45° FOV; color fundus image
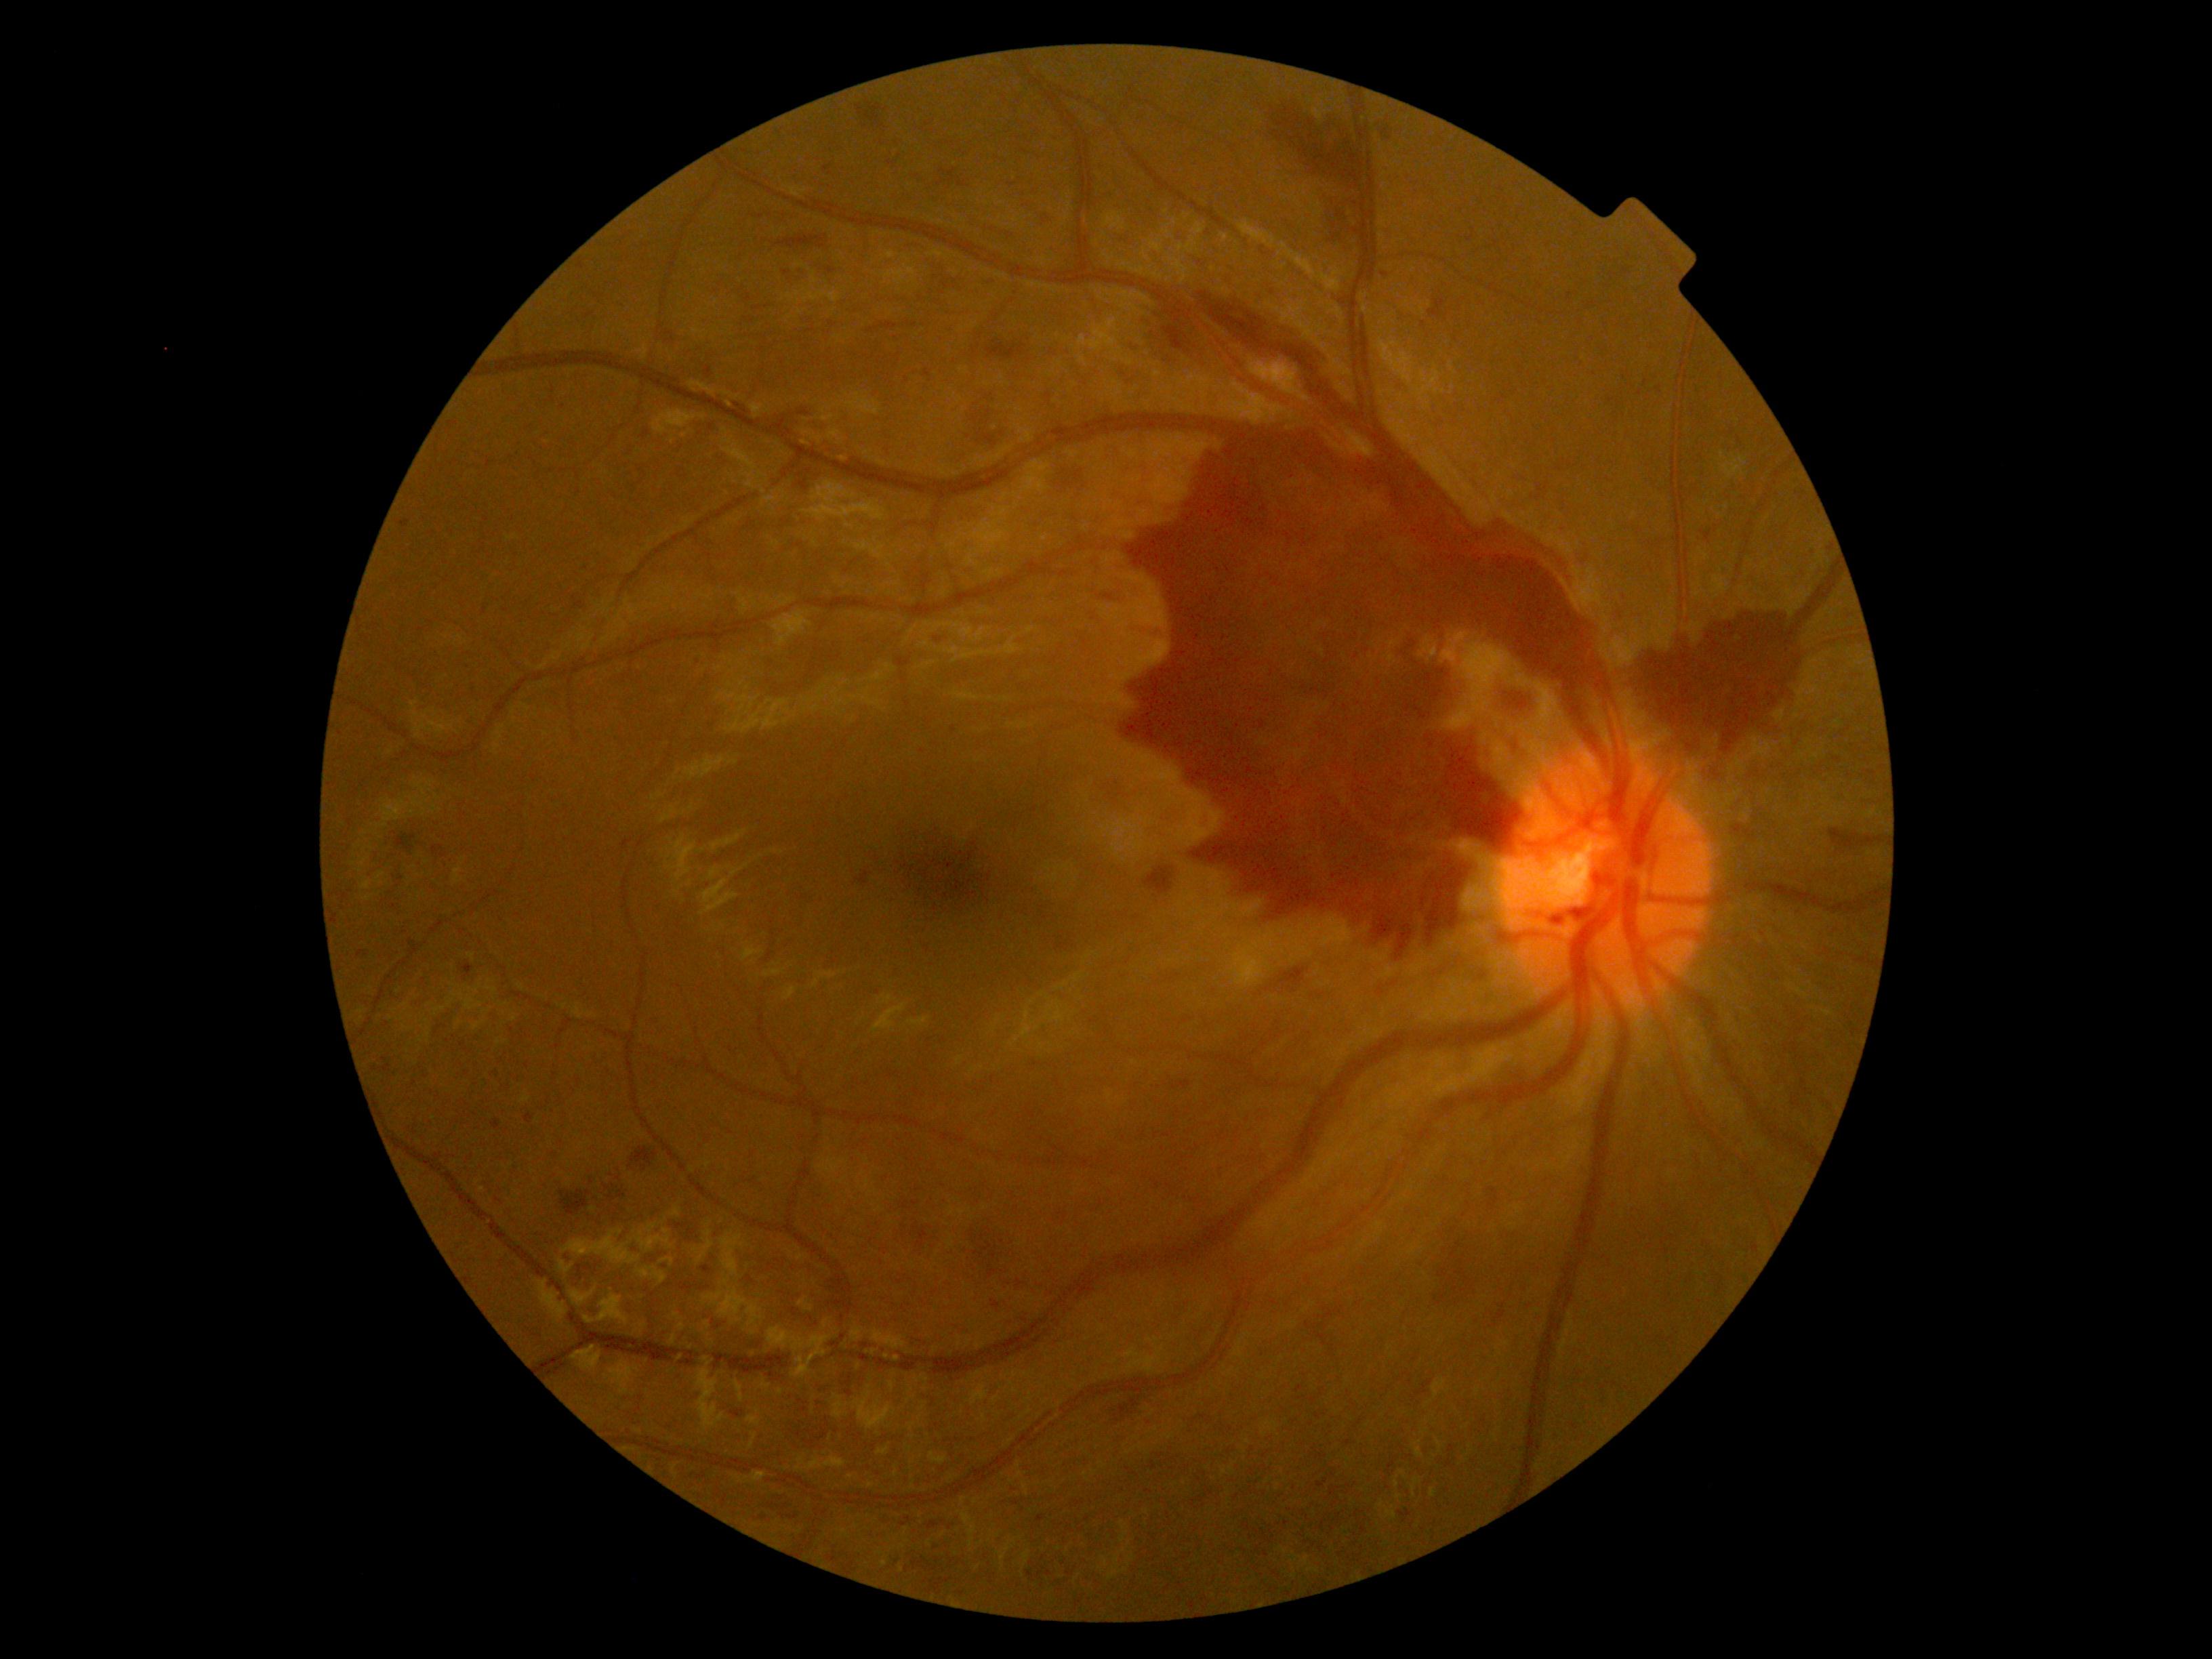

Disease class: proliferative diabetic retinopathy. DR severity is proliferative diabetic retinopathy (grade 4).